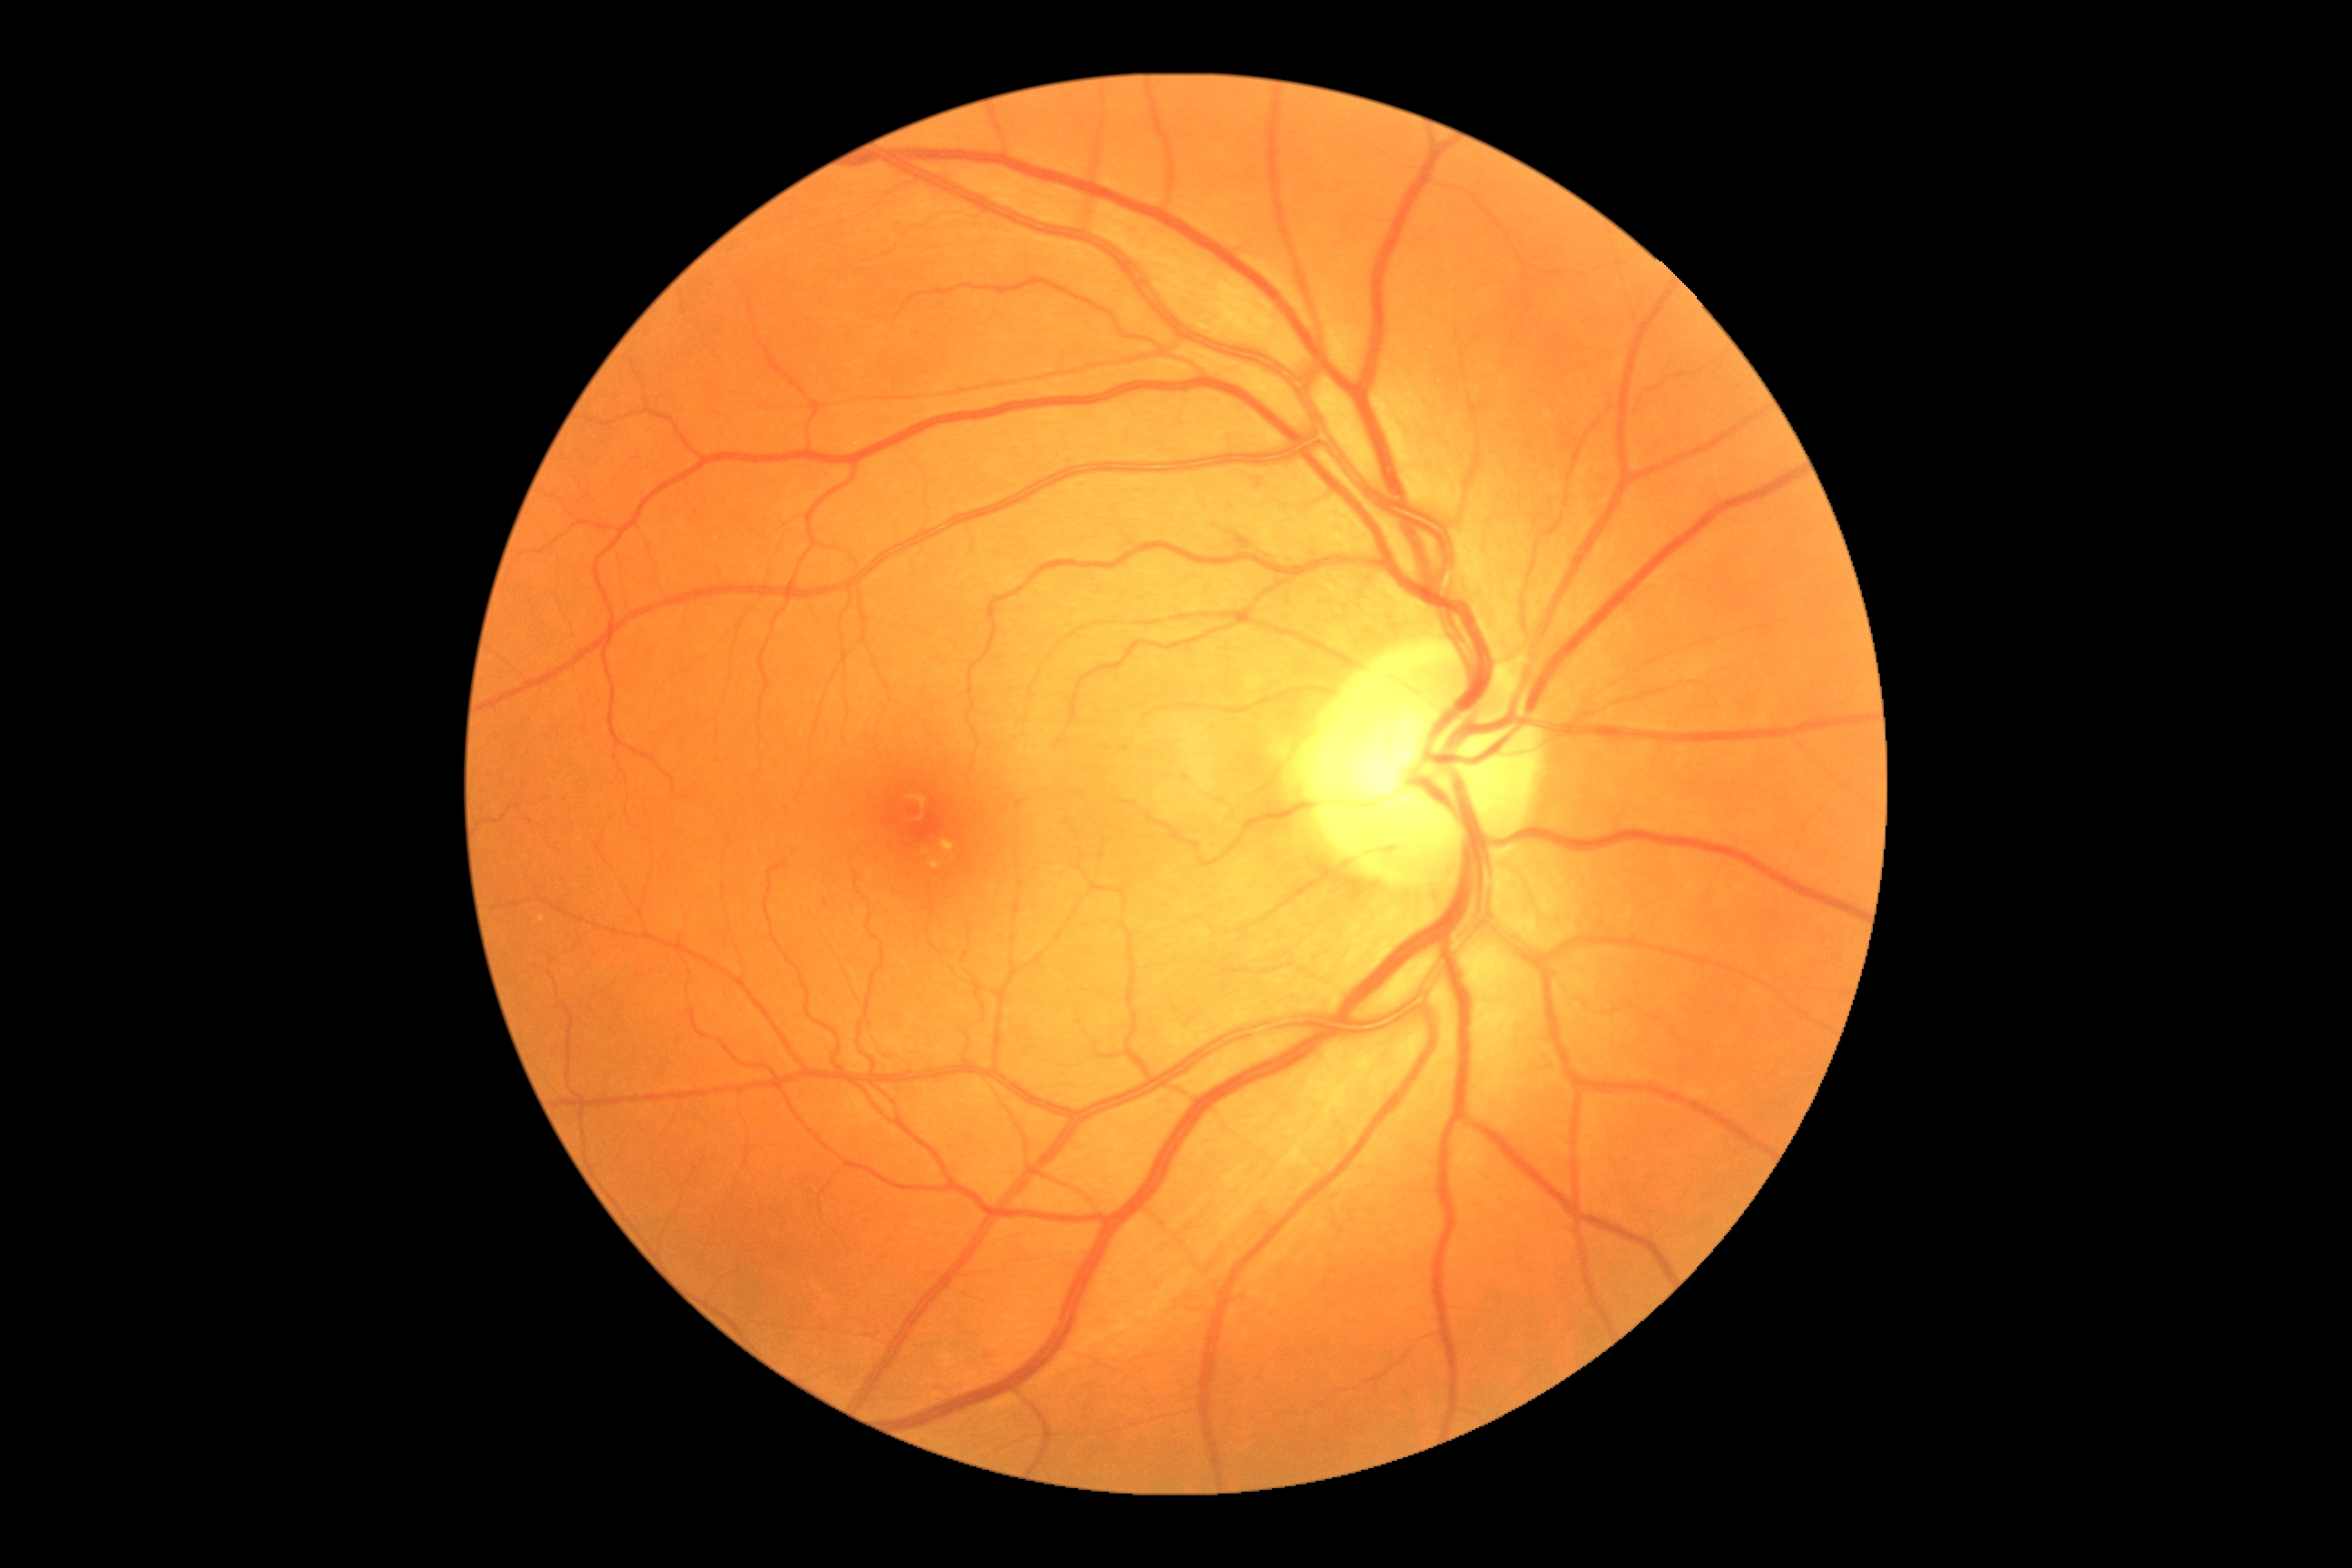
Diabetic retinopathy is grade 0.